Retinal fundus photograph; 2212 x 1659 pixels.
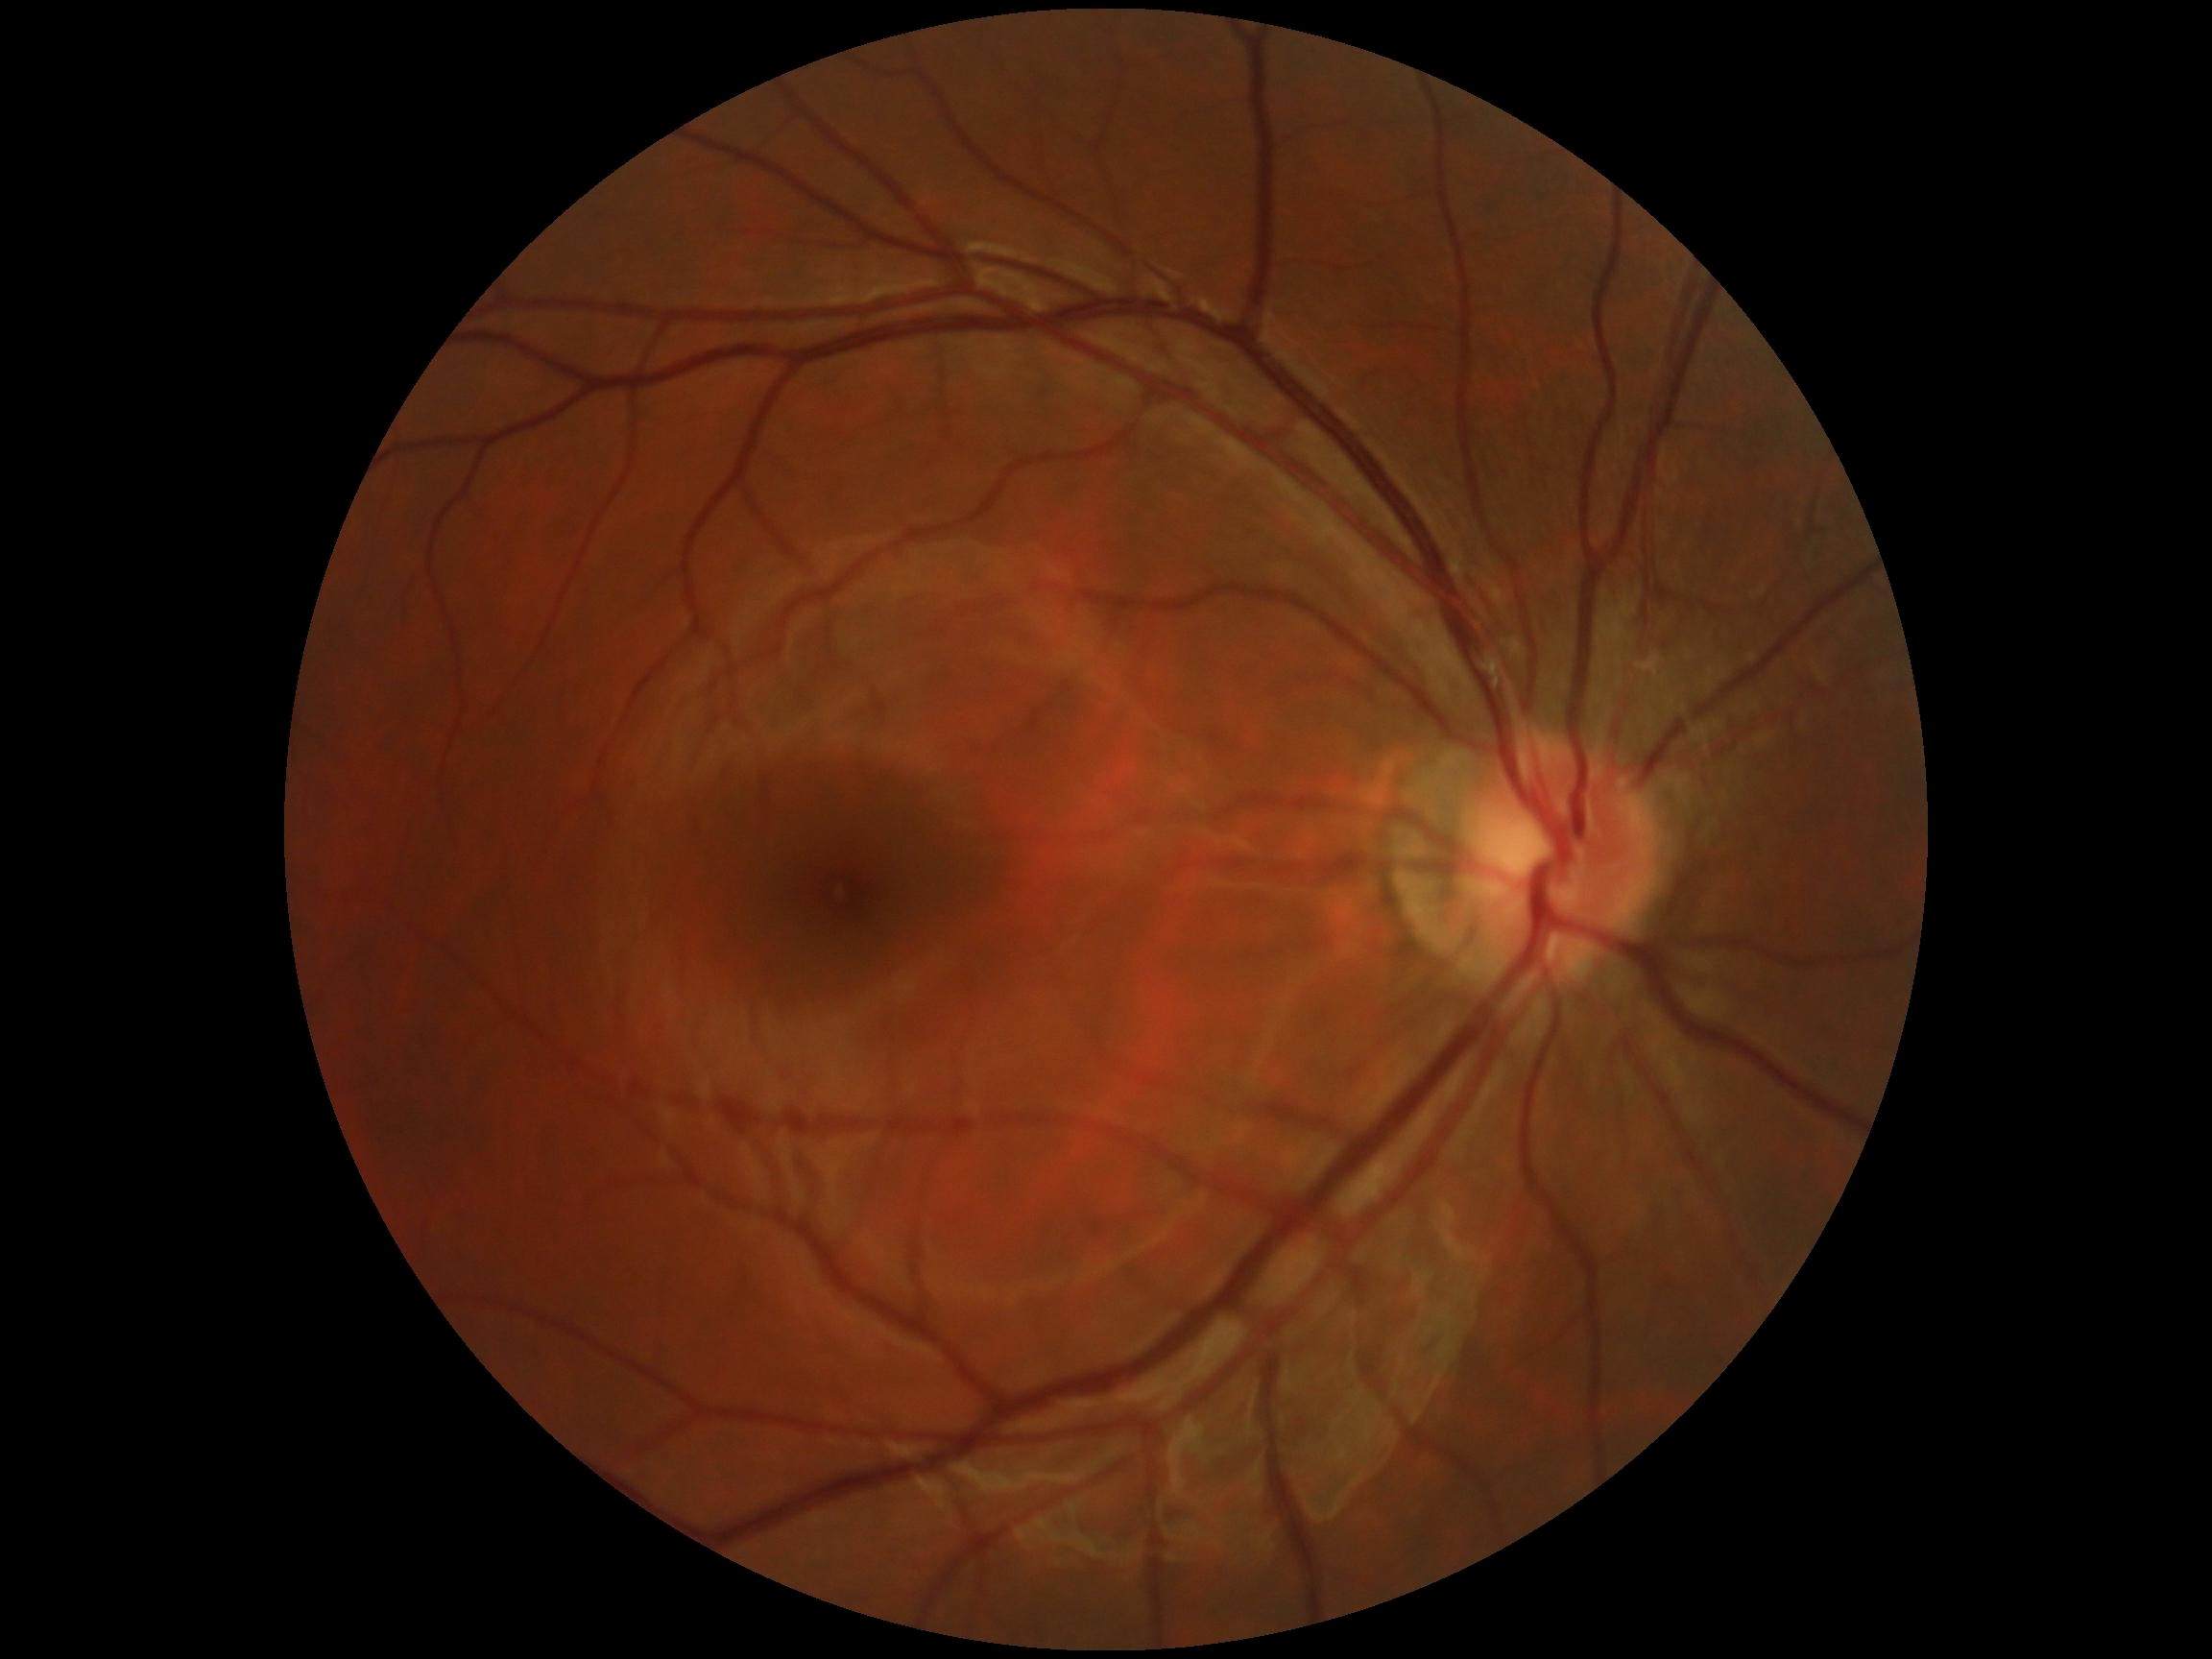

No diabetic retinal disease findings. Retinopathy: grade 0 (no apparent retinopathy).